Image size 848x848, retinal fundus photograph — 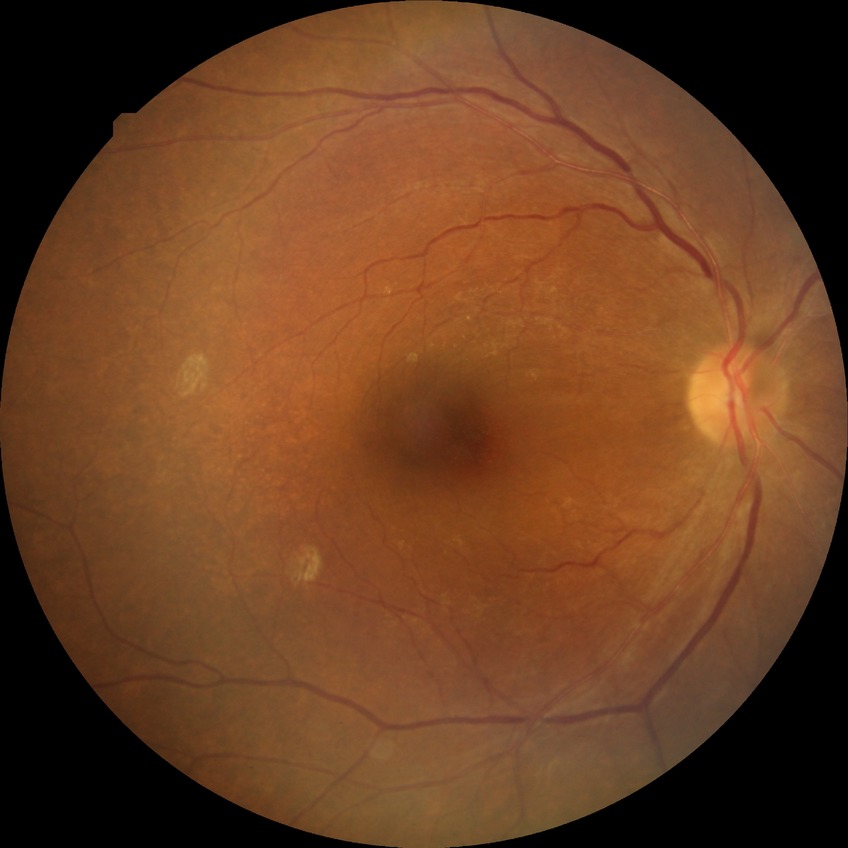
diabetic retinopathy (DR) = NDR (no diabetic retinopathy).